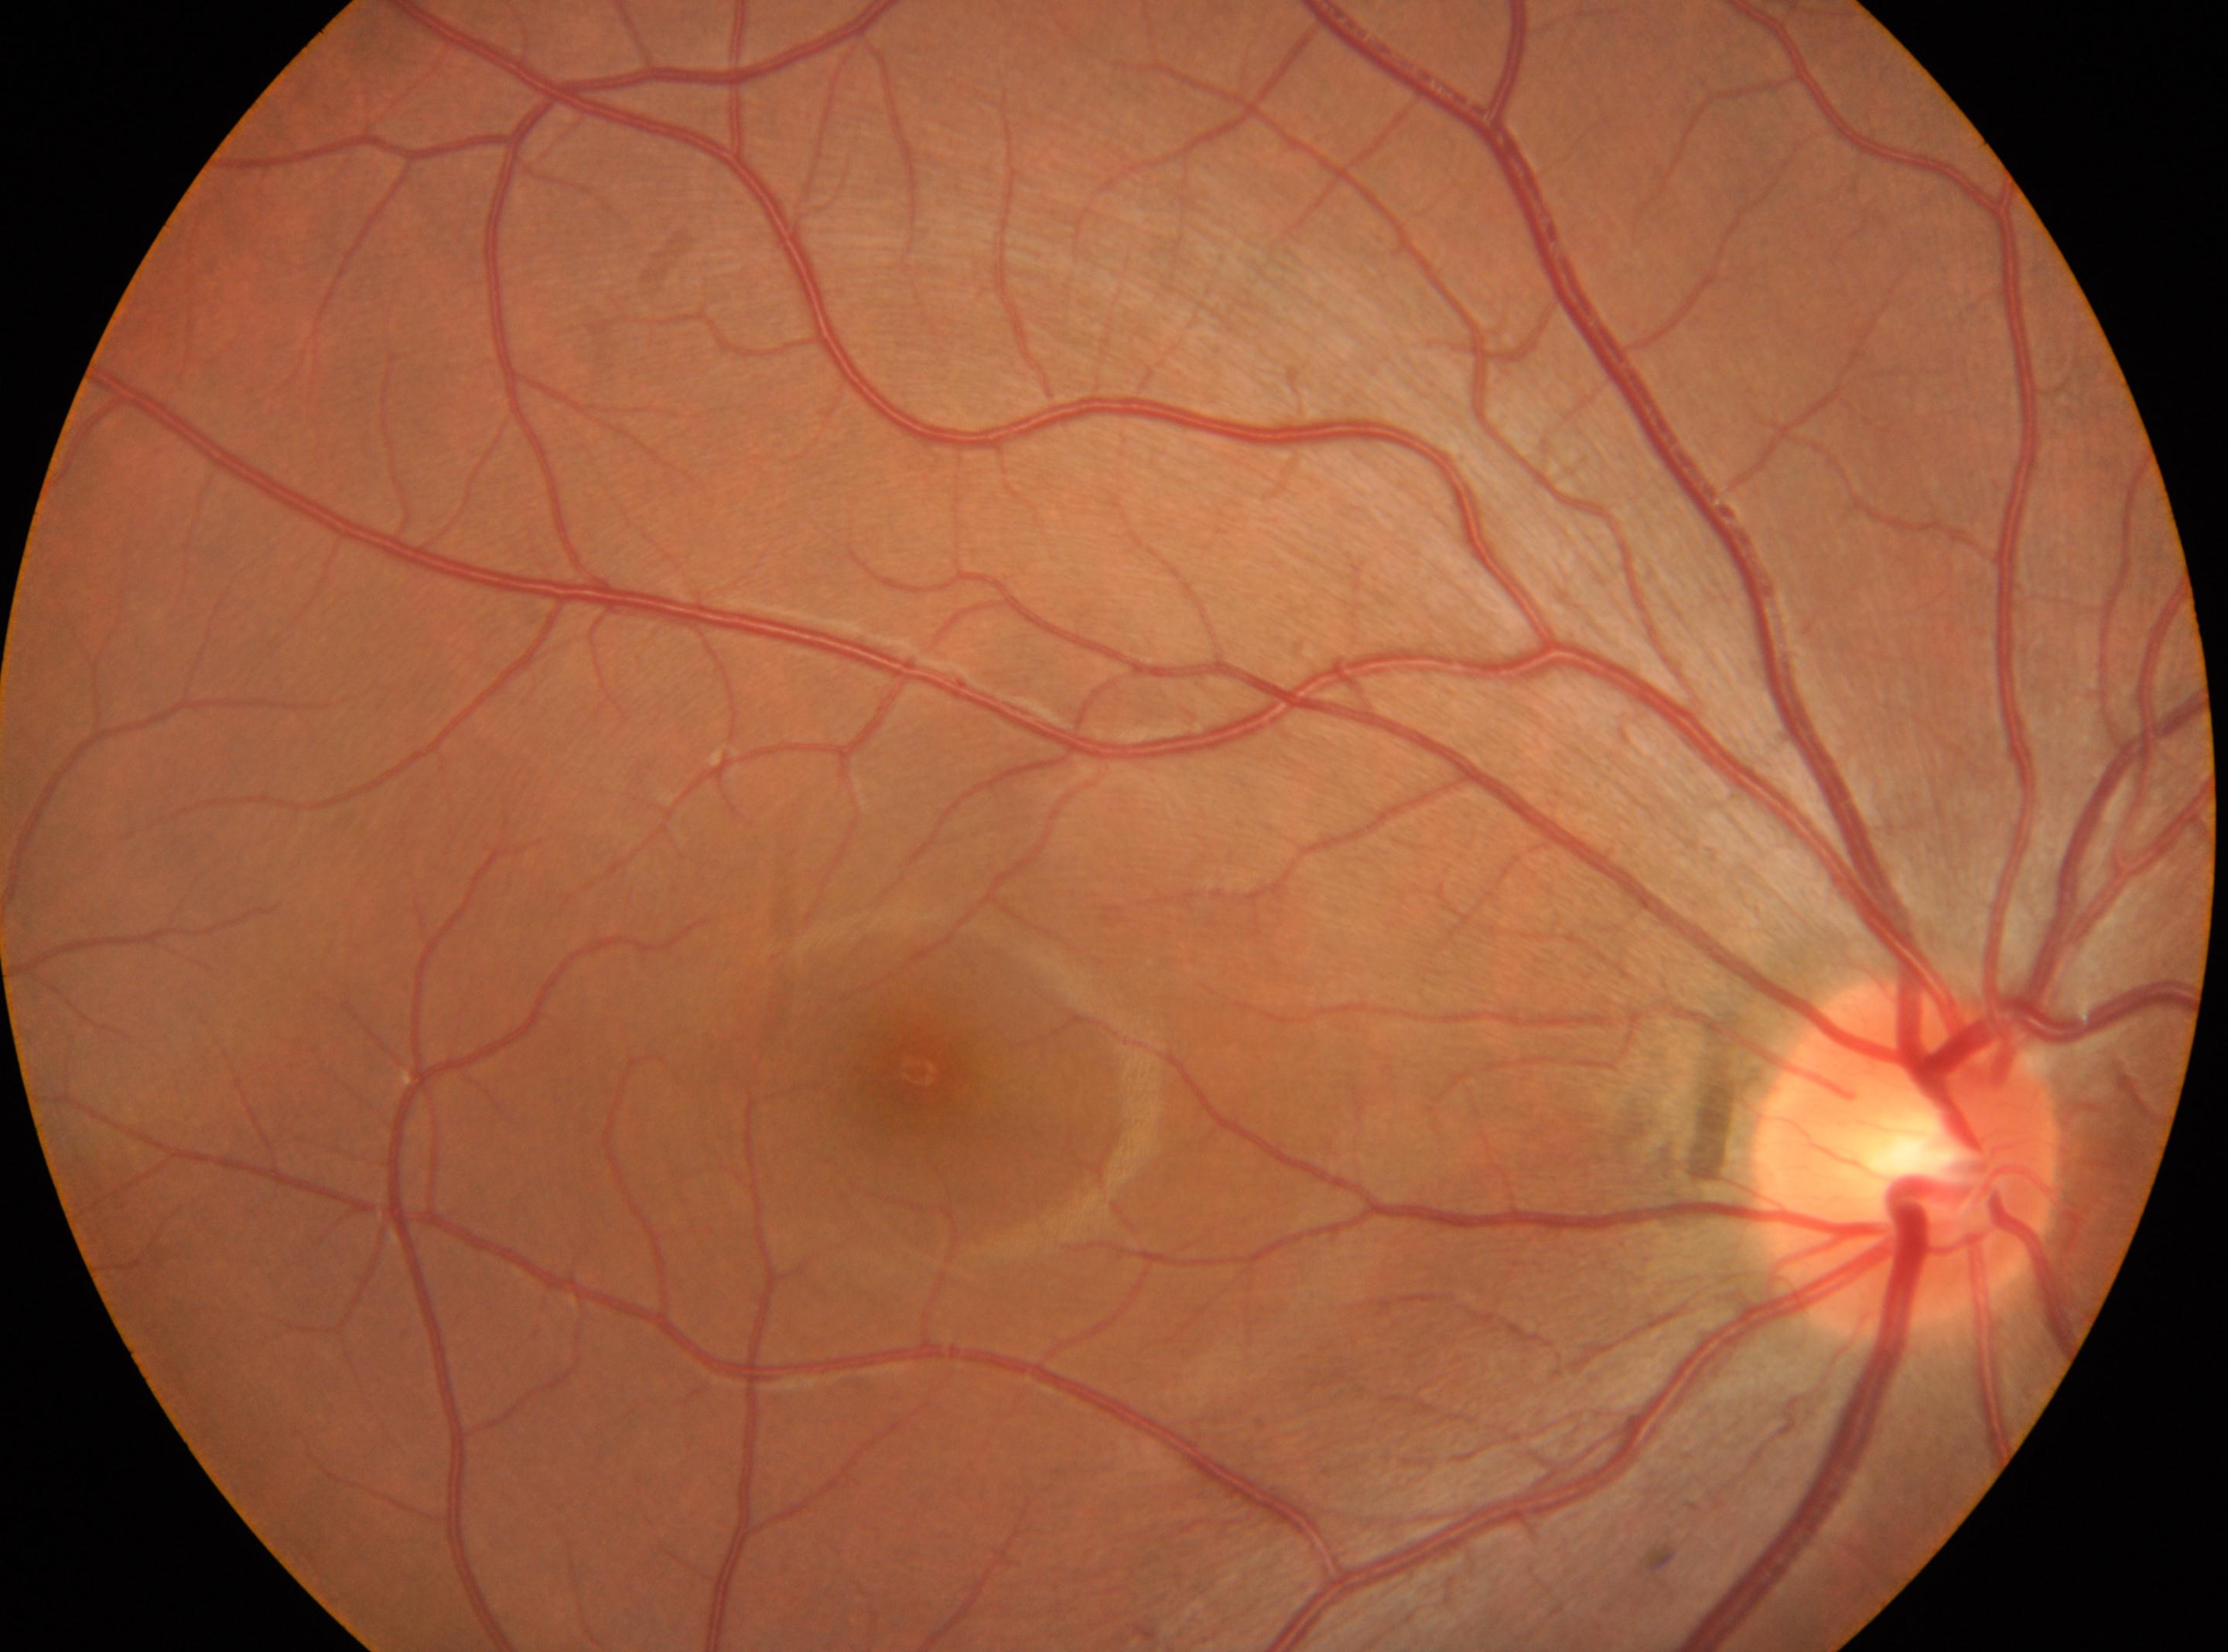 retinopathy: grade 0 (no apparent retinopathy) | fovea center: (x: 919, y: 1070) | laterality: right | the optic disc: (x: 1906, y: 1157).